45° FOV, 2352 by 1568 pixels, CFP — 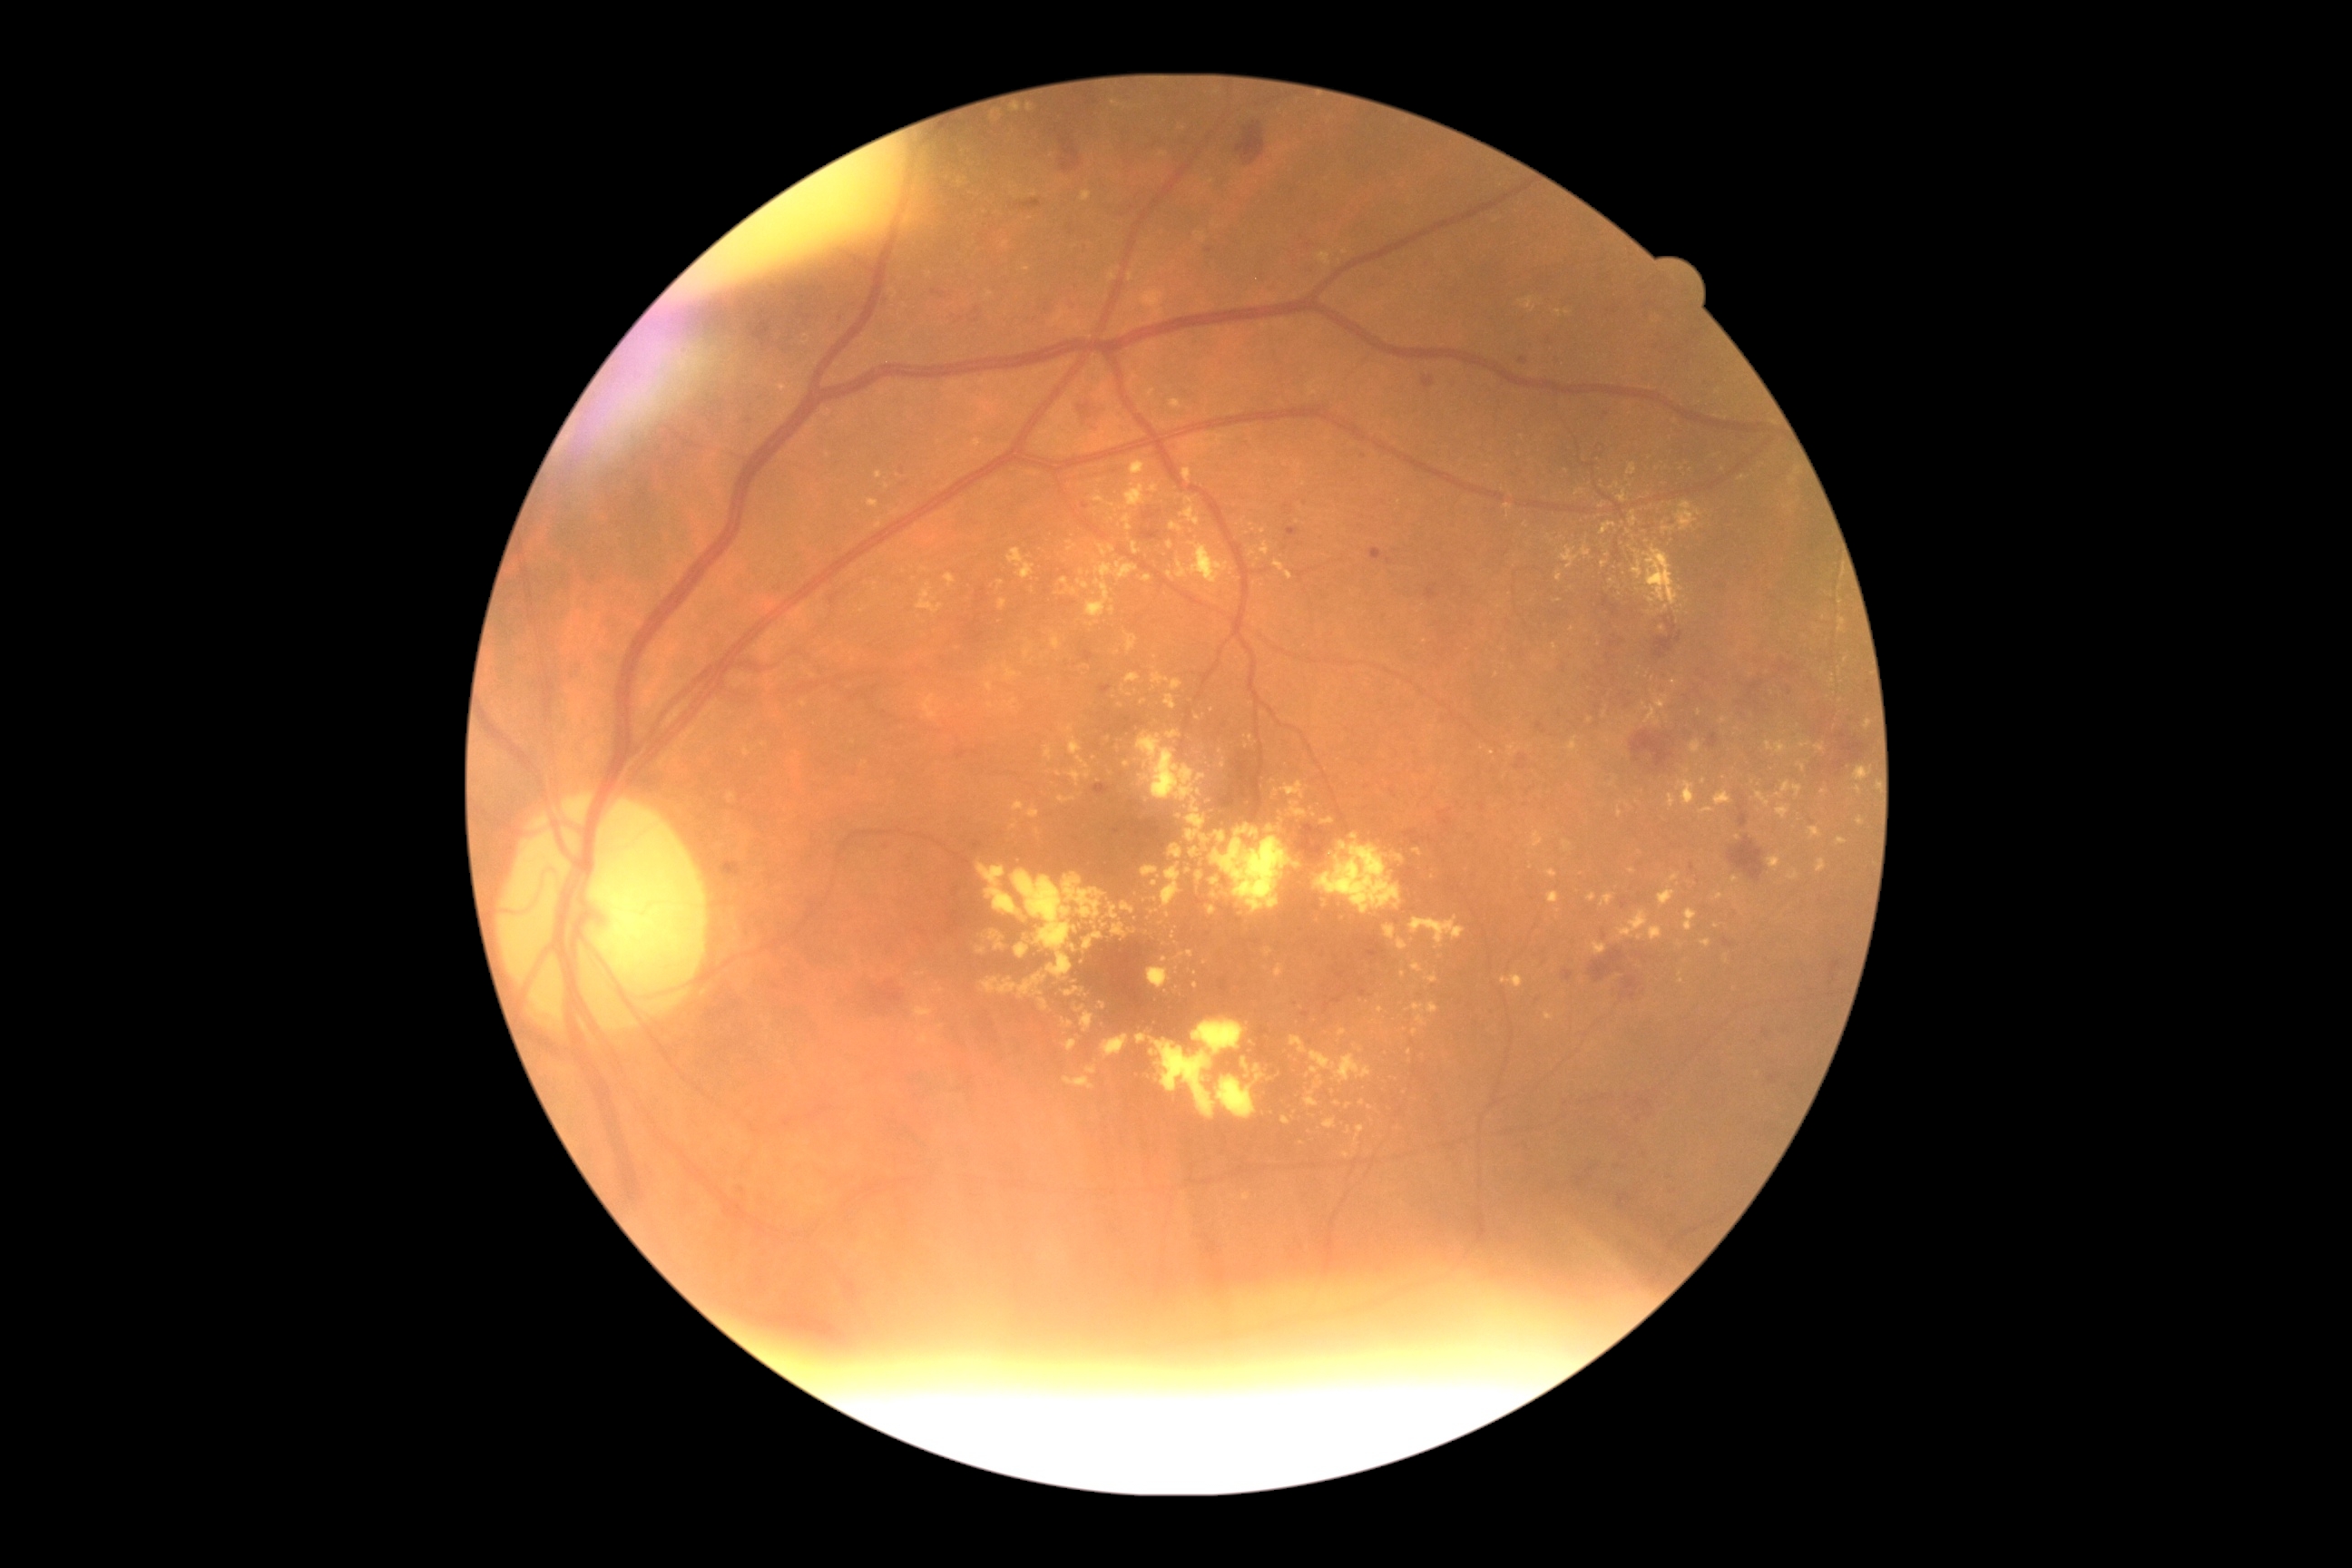

Diabetic retinopathy (DR): 2/4
A subset of detected lesions:
hard exudates (EXs) (subset): (1411,963,1424,974); (1034,992,1043,997); (981,974,1048,999); (1313,897,1324,908); (1014,916,1028,926); (1854,767,1872,783); (1008,700,1017,707); (1776,807,1792,819); (1217,832,1226,843); (1776,781,1803,799); (1190,848,1199,858)
Small EXs approximately at [879,525]; [1629,532]; [929,275]; [1260,1078]; [1633,871]; [1568,313]; [1159,877]; [1143,702]